Wide-field contact fundus photograph of an infant · acquired on the Phoenix ICON · image size 1240x1240 — 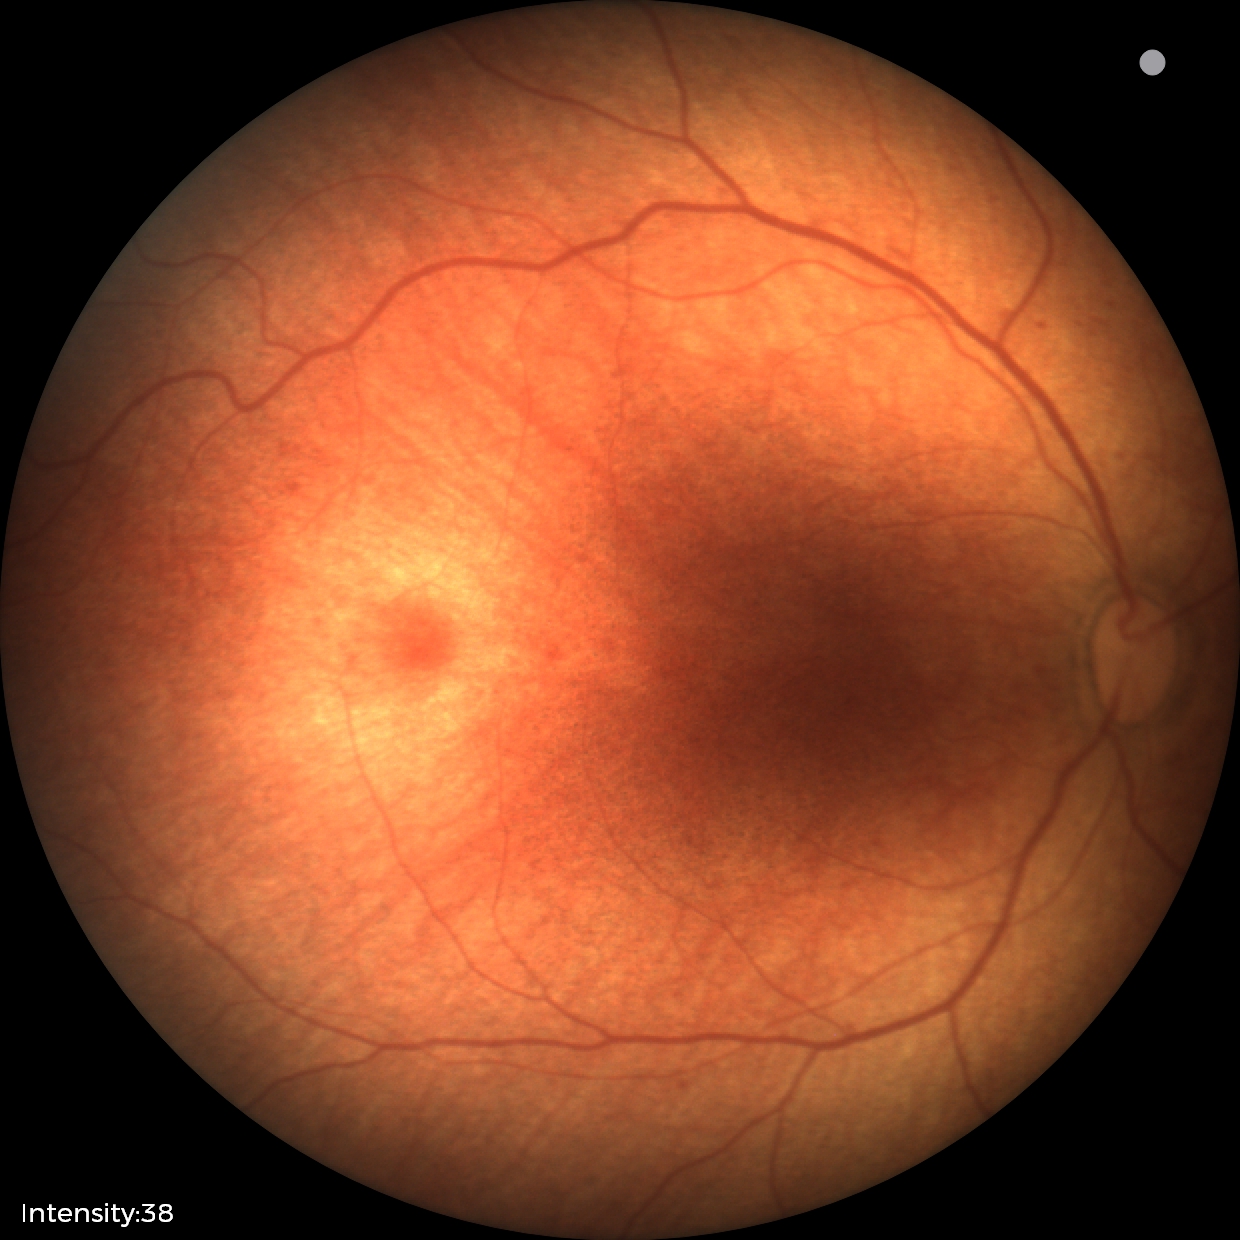
Normal screening examination.